Captured with the Clarity RetCam 3 (130° field of view); wide-field contact fundus photograph of an infant:
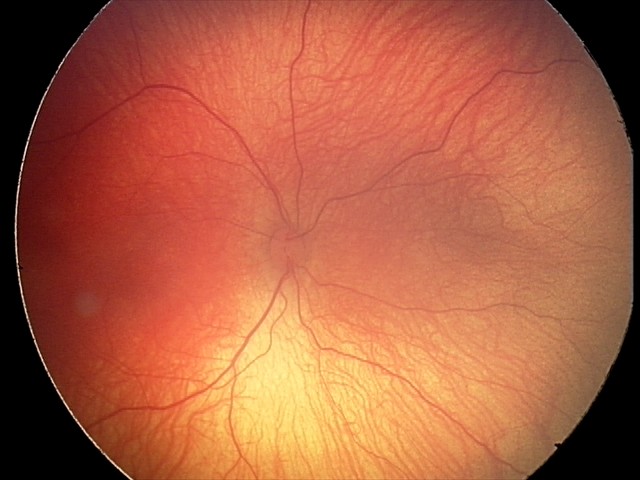
Diagnosis from this screening exam: retinopathy of prematurity stage 2.
Without plus disease.